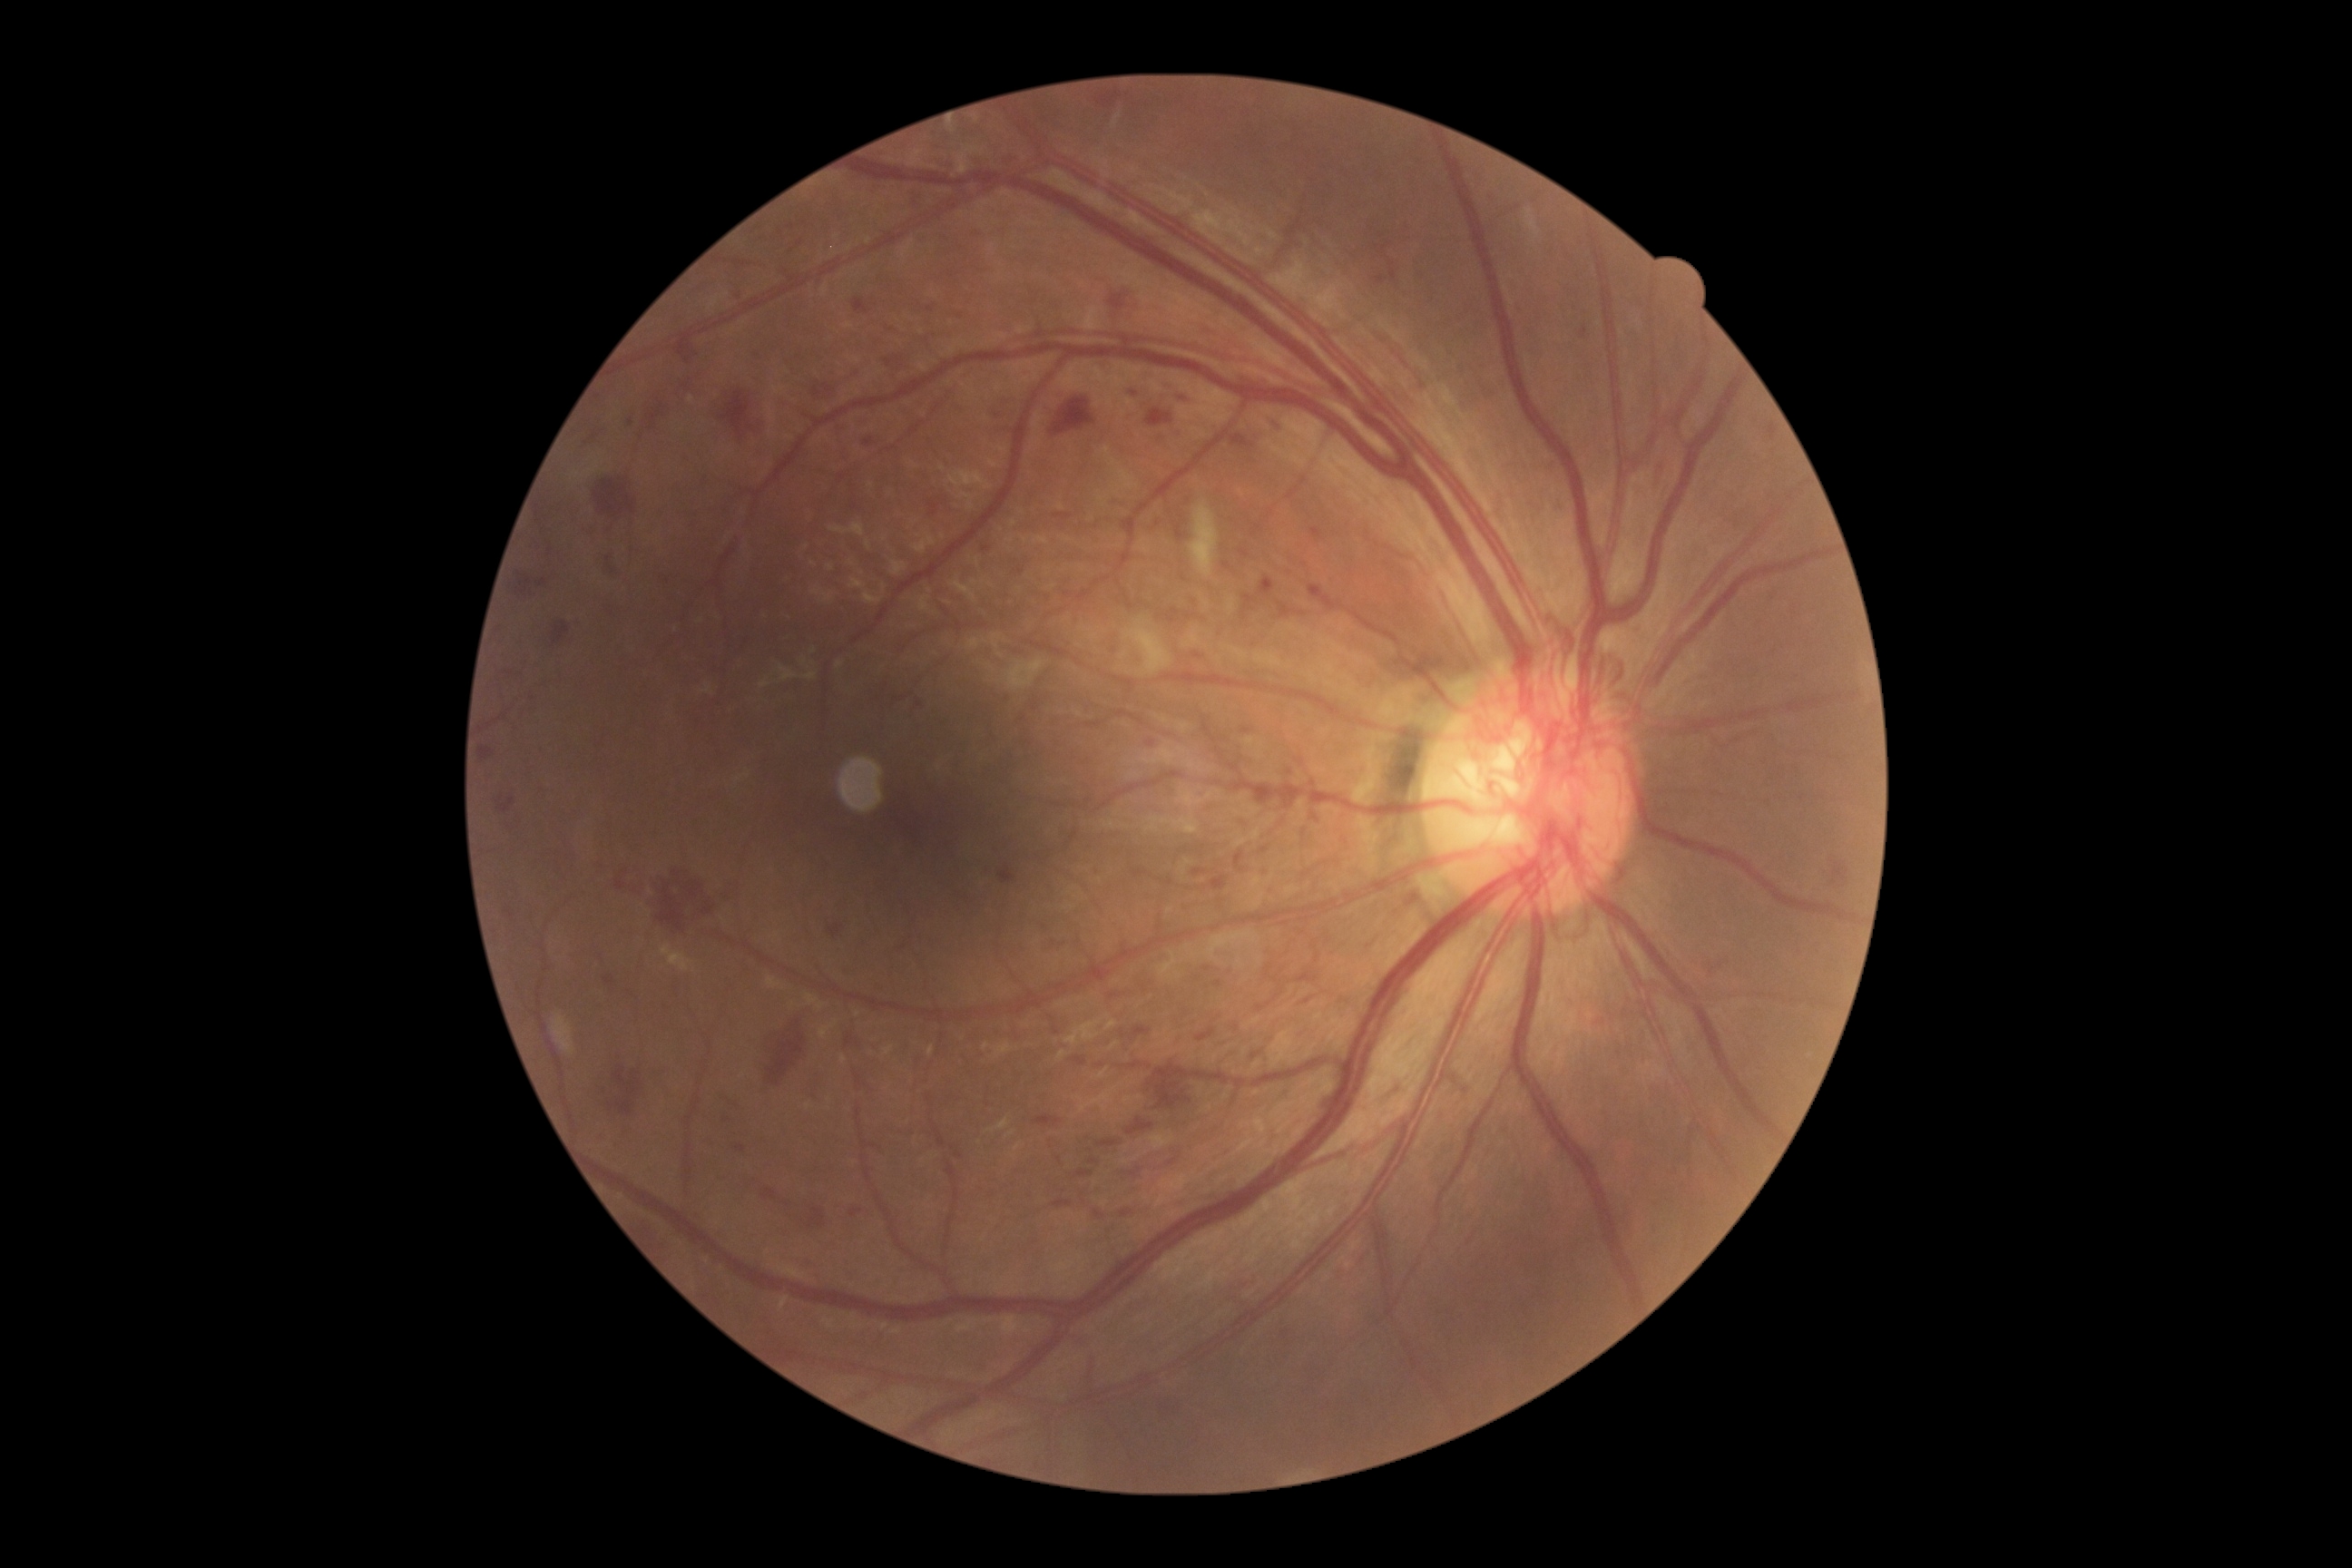
DR stage is PDR (grade 4); proliferative diabetic retinopathy
Lesions identified (partial list):
HEs (subset): {"left": 1110, "top": 295, "right": 1126, "bottom": 309}, {"left": 828, "top": 925, "right": 845, "bottom": 937}, {"left": 1260, "top": 781, "right": 1282, "bottom": 807}, {"left": 1093, "top": 1210, "right": 1106, "bottom": 1220}, {"left": 852, "top": 299, "right": 870, "bottom": 315}, {"left": 1242, "top": 596, "right": 1257, "bottom": 616}, {"left": 594, "top": 480, "right": 636, "bottom": 518}, {"left": 1168, "top": 609, "right": 1181, "bottom": 623}, {"left": 917, "top": 700, "right": 923, "bottom": 709}, {"left": 1055, "top": 513, "right": 1073, "bottom": 520}, {"left": 1054, "top": 1200, "right": 1073, "bottom": 1208}, {"left": 814, "top": 387, "right": 821, "bottom": 398}, {"left": 651, "top": 867, "right": 714, "bottom": 934}, {"left": 514, "top": 569, "right": 545, "bottom": 596}, {"left": 1193, "top": 868, "right": 1206, "bottom": 877}, {"left": 928, "top": 502, "right": 939, "bottom": 516}, {"left": 1830, "top": 861, "right": 1850, "bottom": 885}, {"left": 808, "top": 1208, "right": 827, "bottom": 1230}, {"left": 1257, "top": 995, "right": 1279, "bottom": 1012}
Smaller HEs around Point(1060, 1159)
SEs: {"left": 1188, "top": 502, "right": 1219, "bottom": 580}
MAs: {"left": 926, "top": 308, "right": 934, "bottom": 313}, {"left": 1582, "top": 328, "right": 1589, "bottom": 340}, {"left": 1311, "top": 529, "right": 1324, "bottom": 540}, {"left": 1130, "top": 387, "right": 1142, "bottom": 397}, {"left": 629, "top": 418, "right": 634, "bottom": 427}, {"left": 1260, "top": 847, "right": 1269, "bottom": 856}, {"left": 605, "top": 975, "right": 616, "bottom": 986}, {"left": 1146, "top": 741, "right": 1157, "bottom": 747}, {"left": 736, "top": 1146, "right": 745, "bottom": 1153}
Smaller MAs around Point(800, 244), Point(792, 227), Point(986, 550), Point(805, 223), Point(962, 317), Point(729, 1120)
EXs: none detected